Color fundus image.
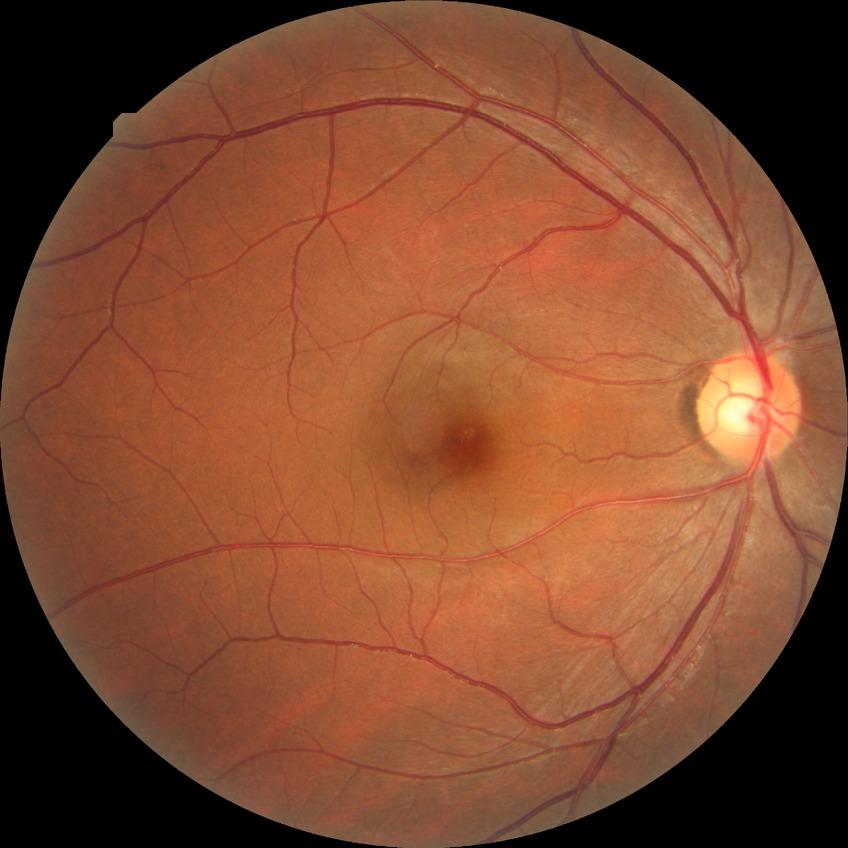
diabetic retinopathy (DR)=no diabetic retinopathy (NDR).